45° FOV; 2048 x 1536 pixels; retinal fundus photograph.
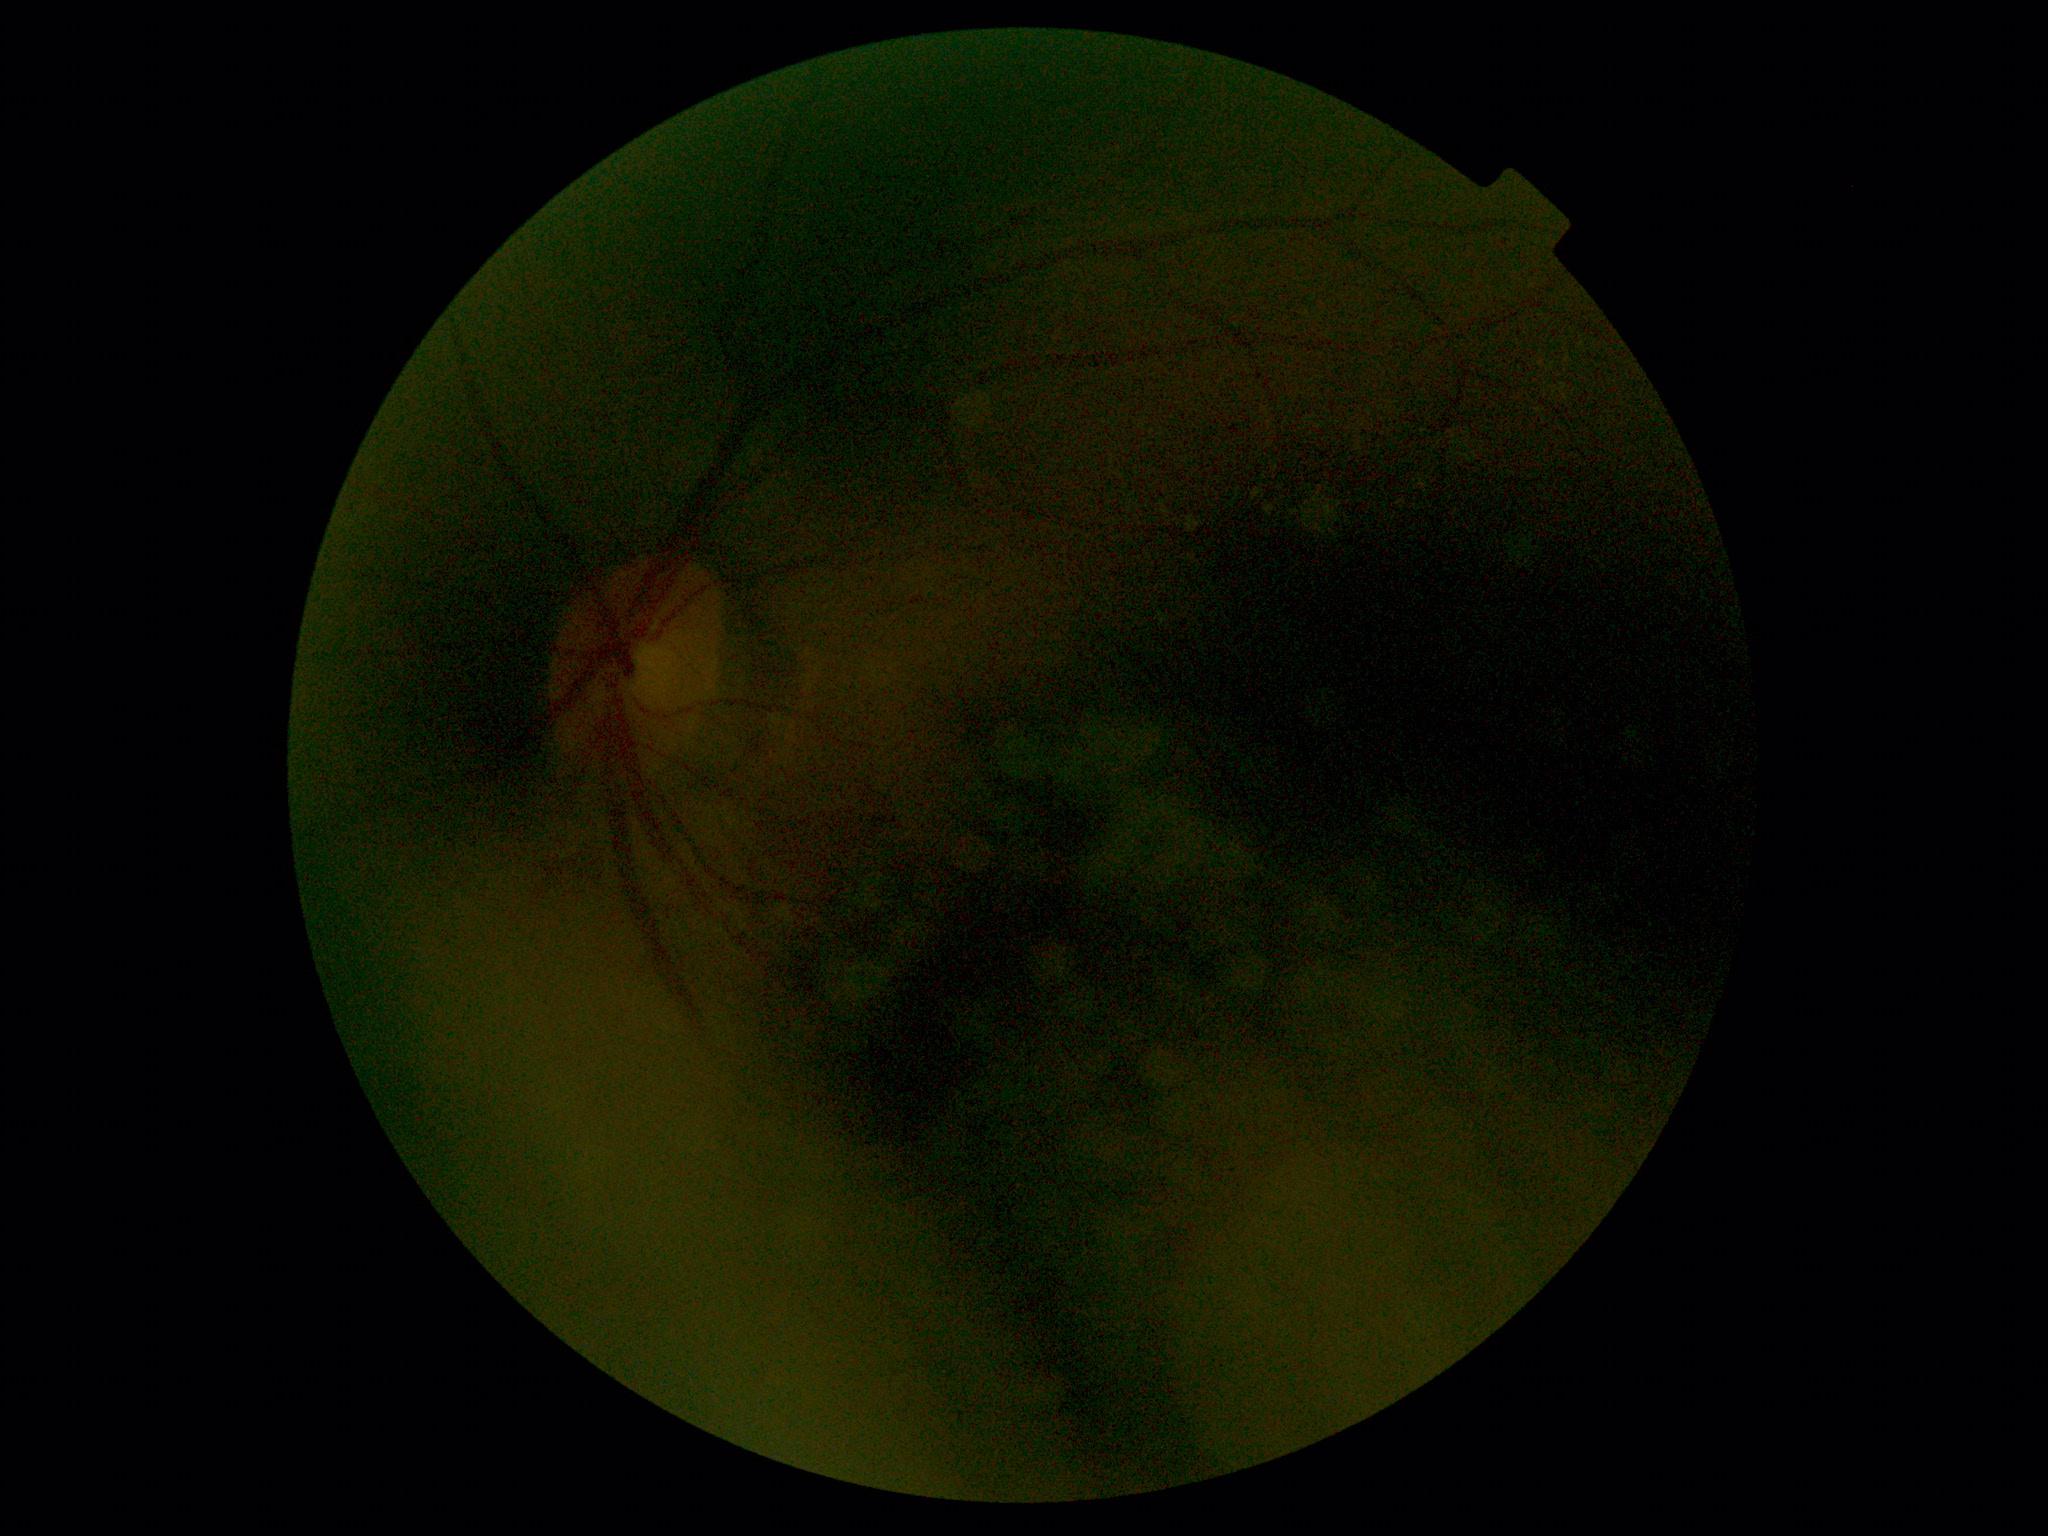 Diabetic retinopathy (DR): grade 2 (moderate NPDR).